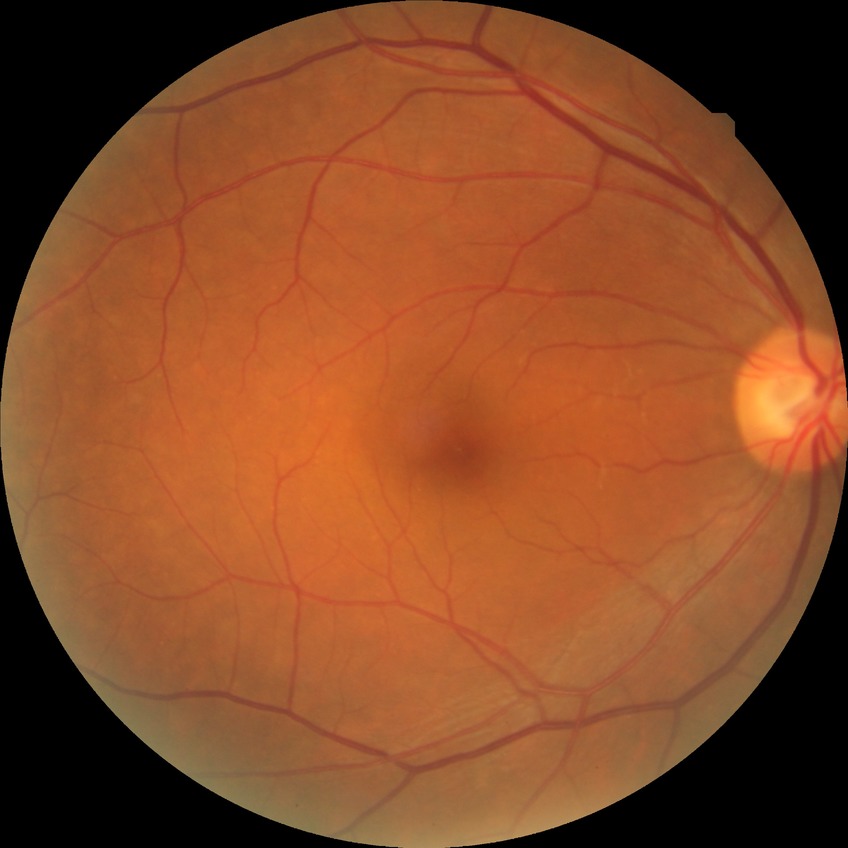
Davis grading is no diabetic retinopathy.